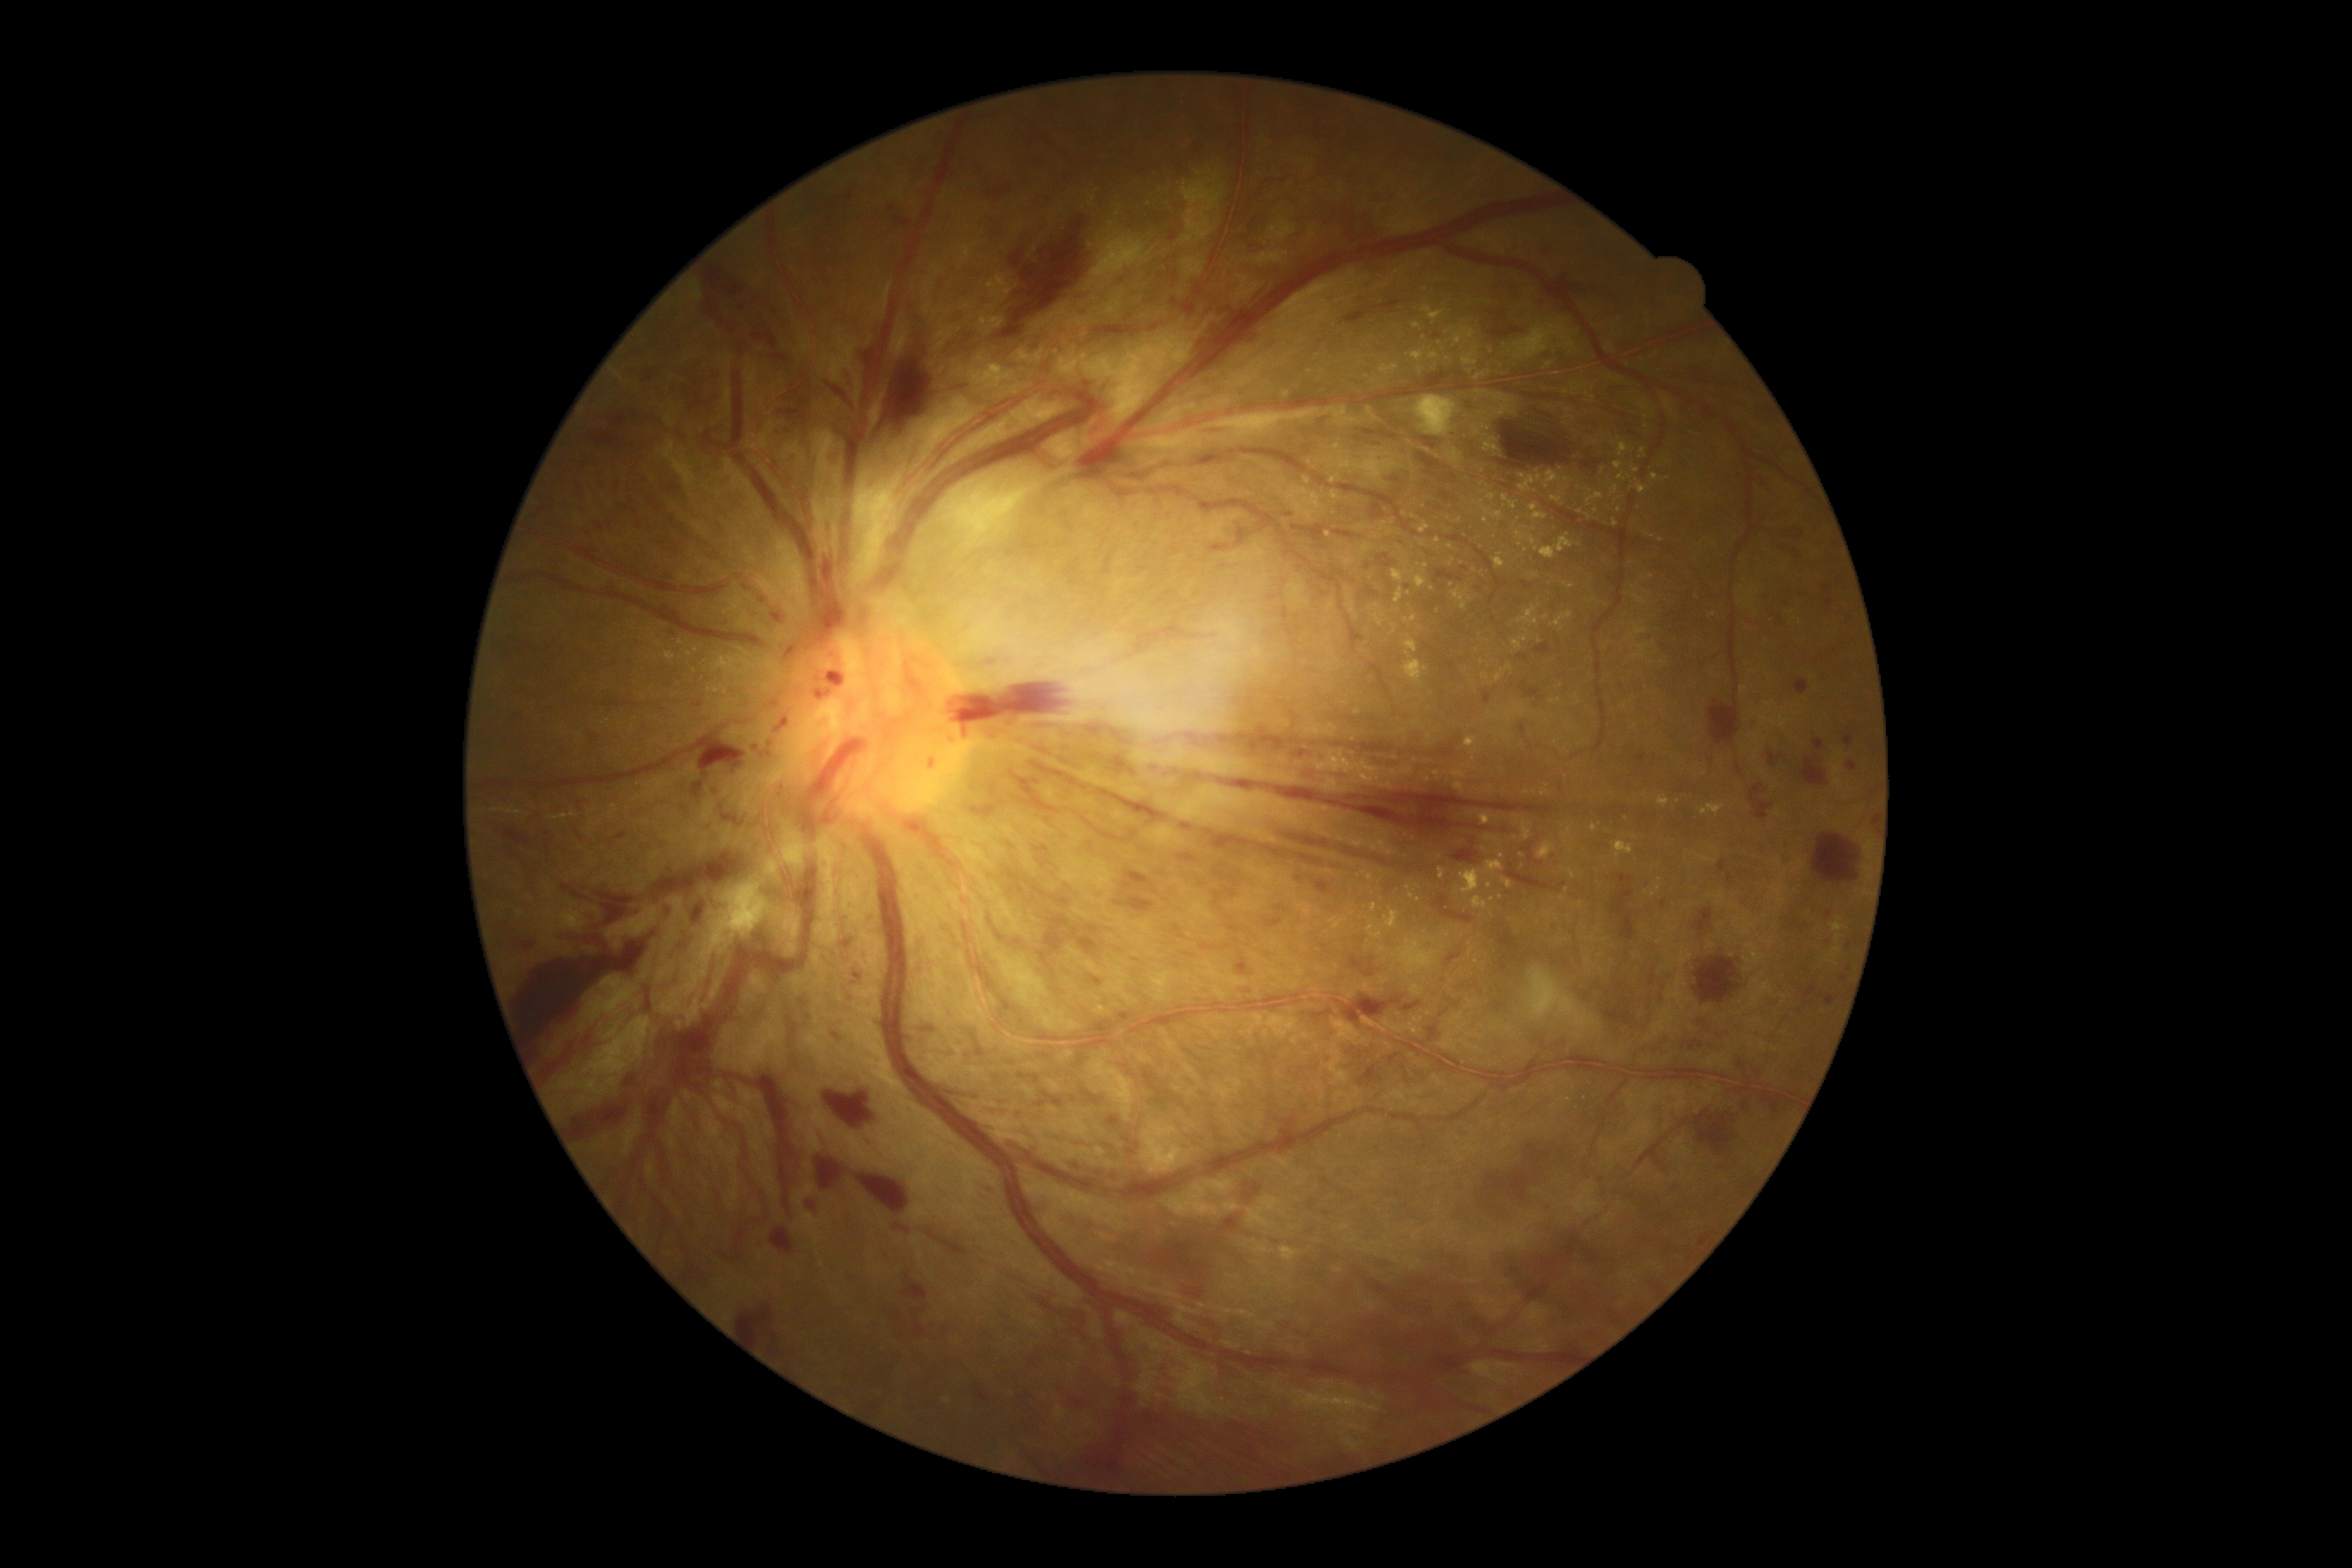

<lesions partial="true">
  <dr_grade>4</dr_grade>
  <he partial="true">bbox=(1210, 544, 1230, 554), bbox=(634, 522, 646, 530), bbox=(1672, 1185, 1679, 1194), bbox=(1357, 1067, 1385, 1089), bbox=(1065, 1368, 1113, 1411), bbox=(1801, 757, 1830, 787), bbox=(1019, 885, 1024, 893), bbox=(1376, 554, 1395, 568), bbox=(1383, 1051, 1399, 1060), bbox=(1844, 735, 1853, 745), bbox=(671, 479, 689, 506), bbox=(699, 744, 740, 778), bbox=(1768, 754, 1782, 768), bbox=(596, 848, 756, 926), bbox=(1785, 530, 1804, 539), bbox=(842, 365, 857, 389), bbox=(1019, 1074, 1029, 1081), bbox=(976, 1385, 989, 1406)</he>
  <he_small>(1011, 845)</he_small>
  <ex partial="true">bbox=(1619, 444, 1629, 458), bbox=(1332, 491, 1342, 501), bbox=(1517, 606, 1540, 627), bbox=(1032, 346, 1043, 364), bbox=(1564, 584, 1574, 591), bbox=(1473, 897, 1488, 910), bbox=(1462, 346, 1478, 365), bbox=(1481, 487, 1490, 494), bbox=(1407, 886, 1414, 898)</ex>
  <ex_small>(1679, 802), (657, 780), (1483, 470), (1450, 546), (1589, 490), (1364, 652), (680, 643), (1619, 510), (658, 645), (1653, 894), (1474, 570)</ex_small>
</lesions>